1240x1240. Wide-field contact fundus photograph of an infant.
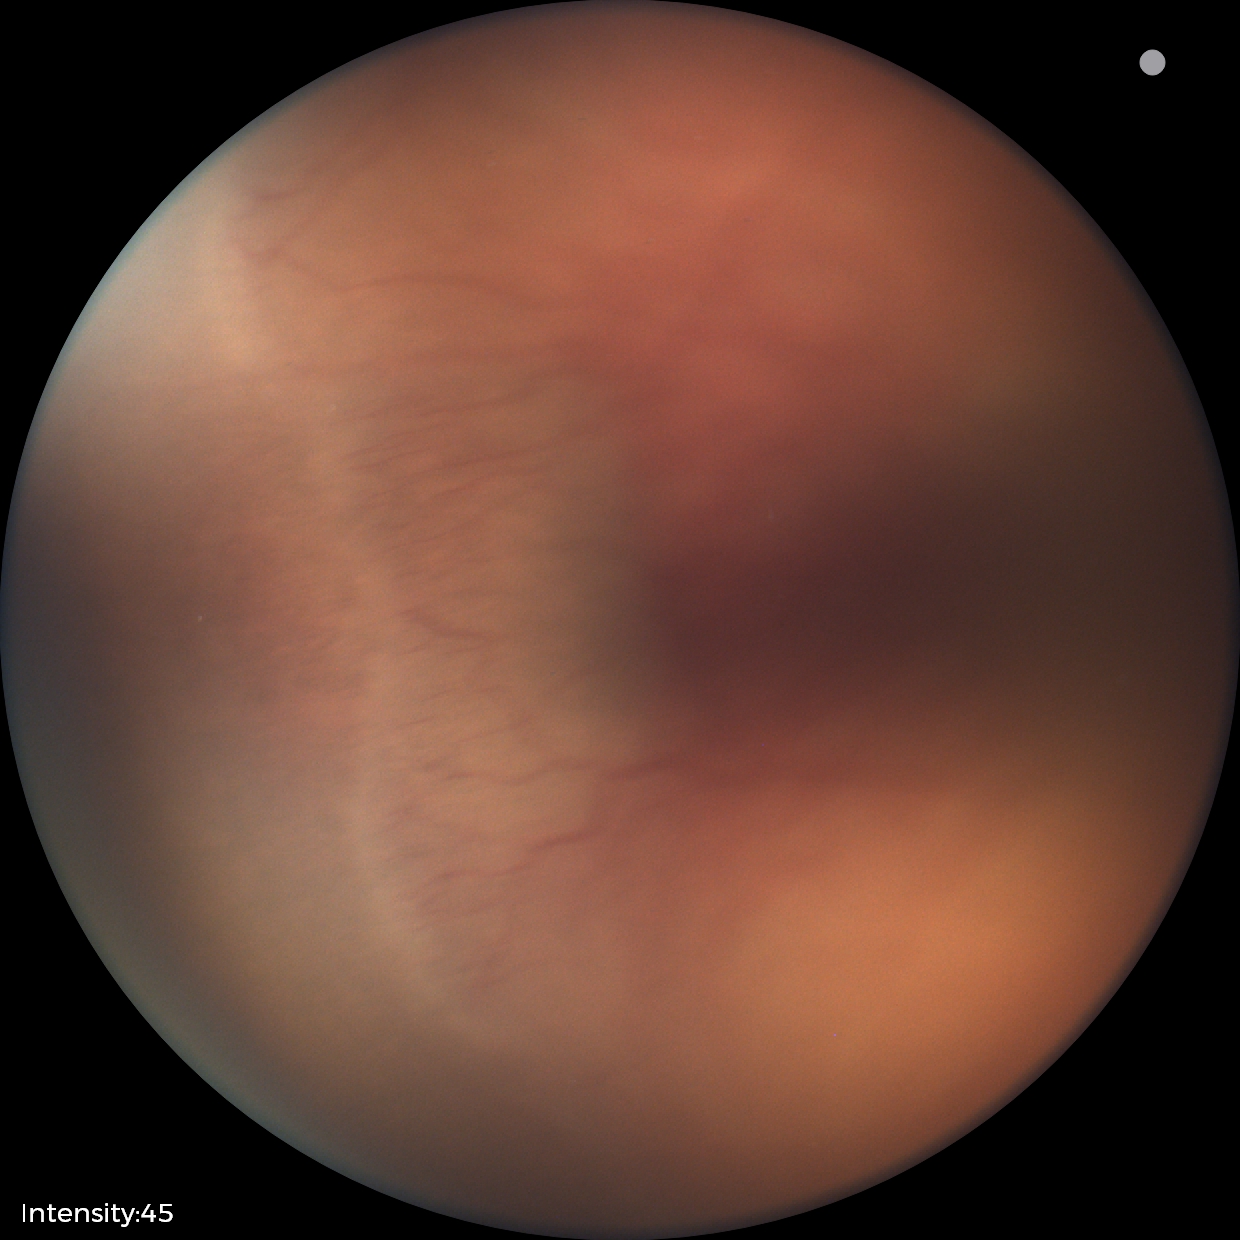

Plus disease absent. Diagnosis from this screening exam: ROP stage 2 — ridge with height and width at the demarcation line.